Color fundus image: 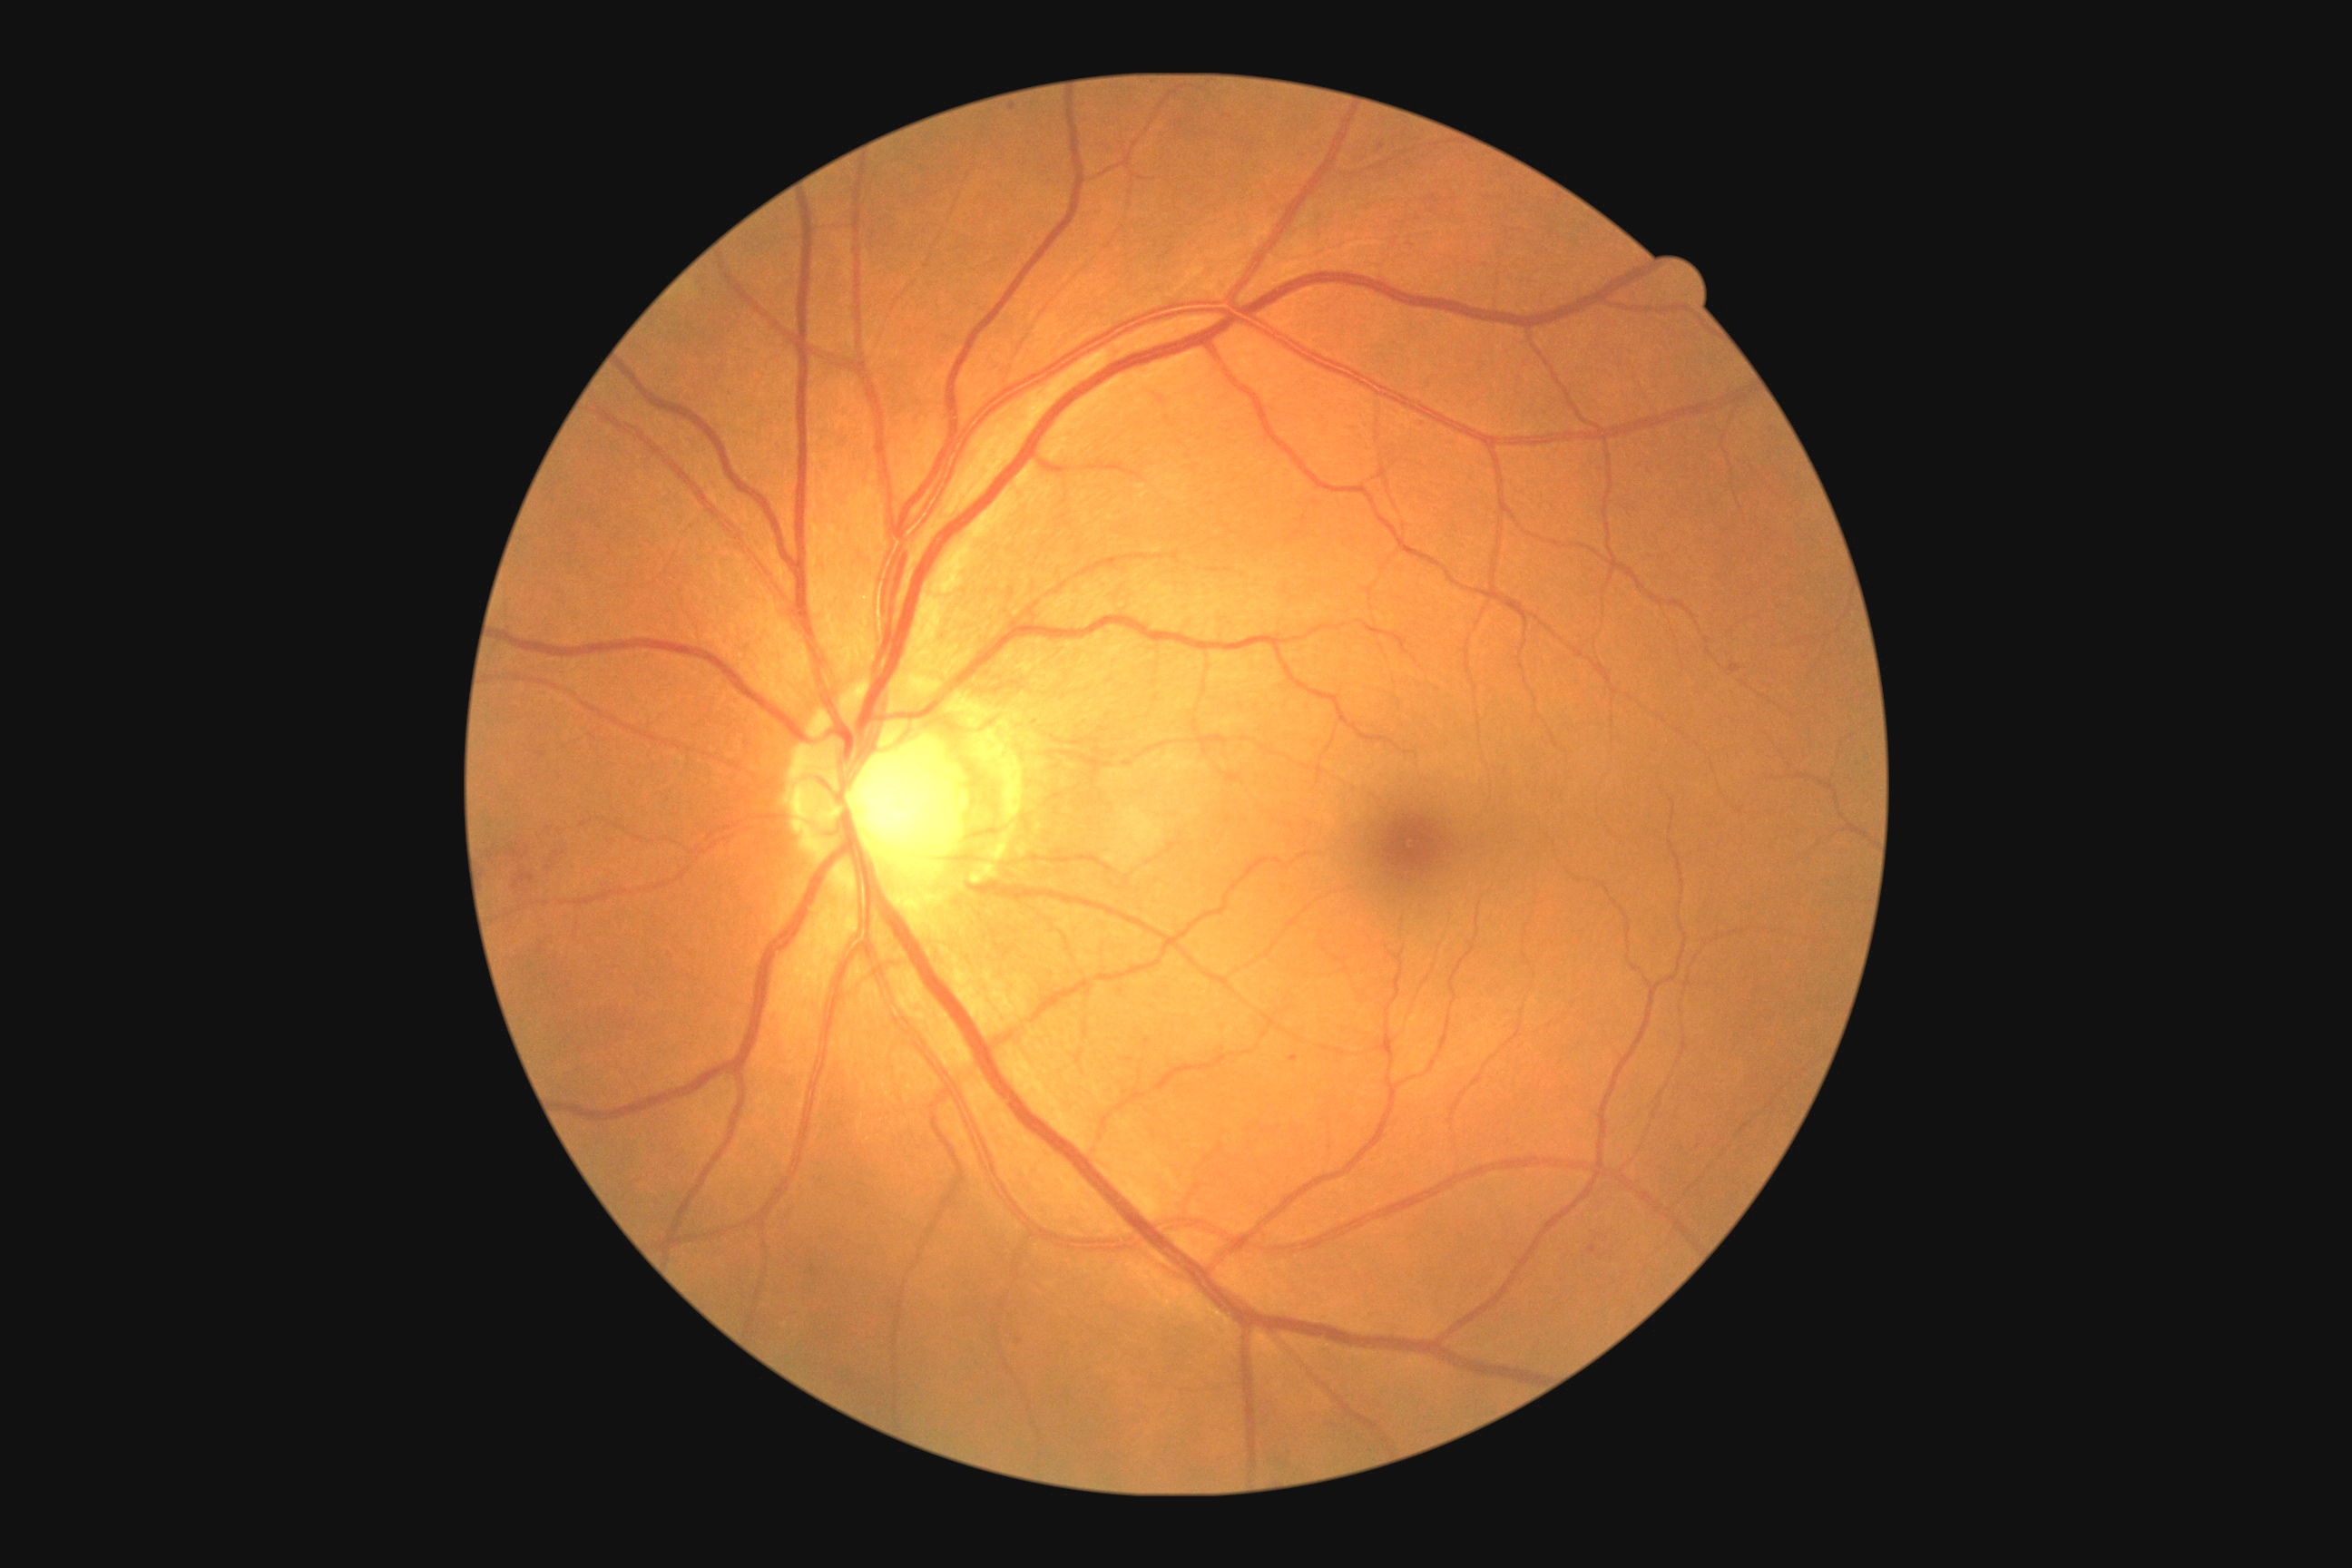 Annotations:
– diabetic retinopathy severity: grade 2